Fundus photo — 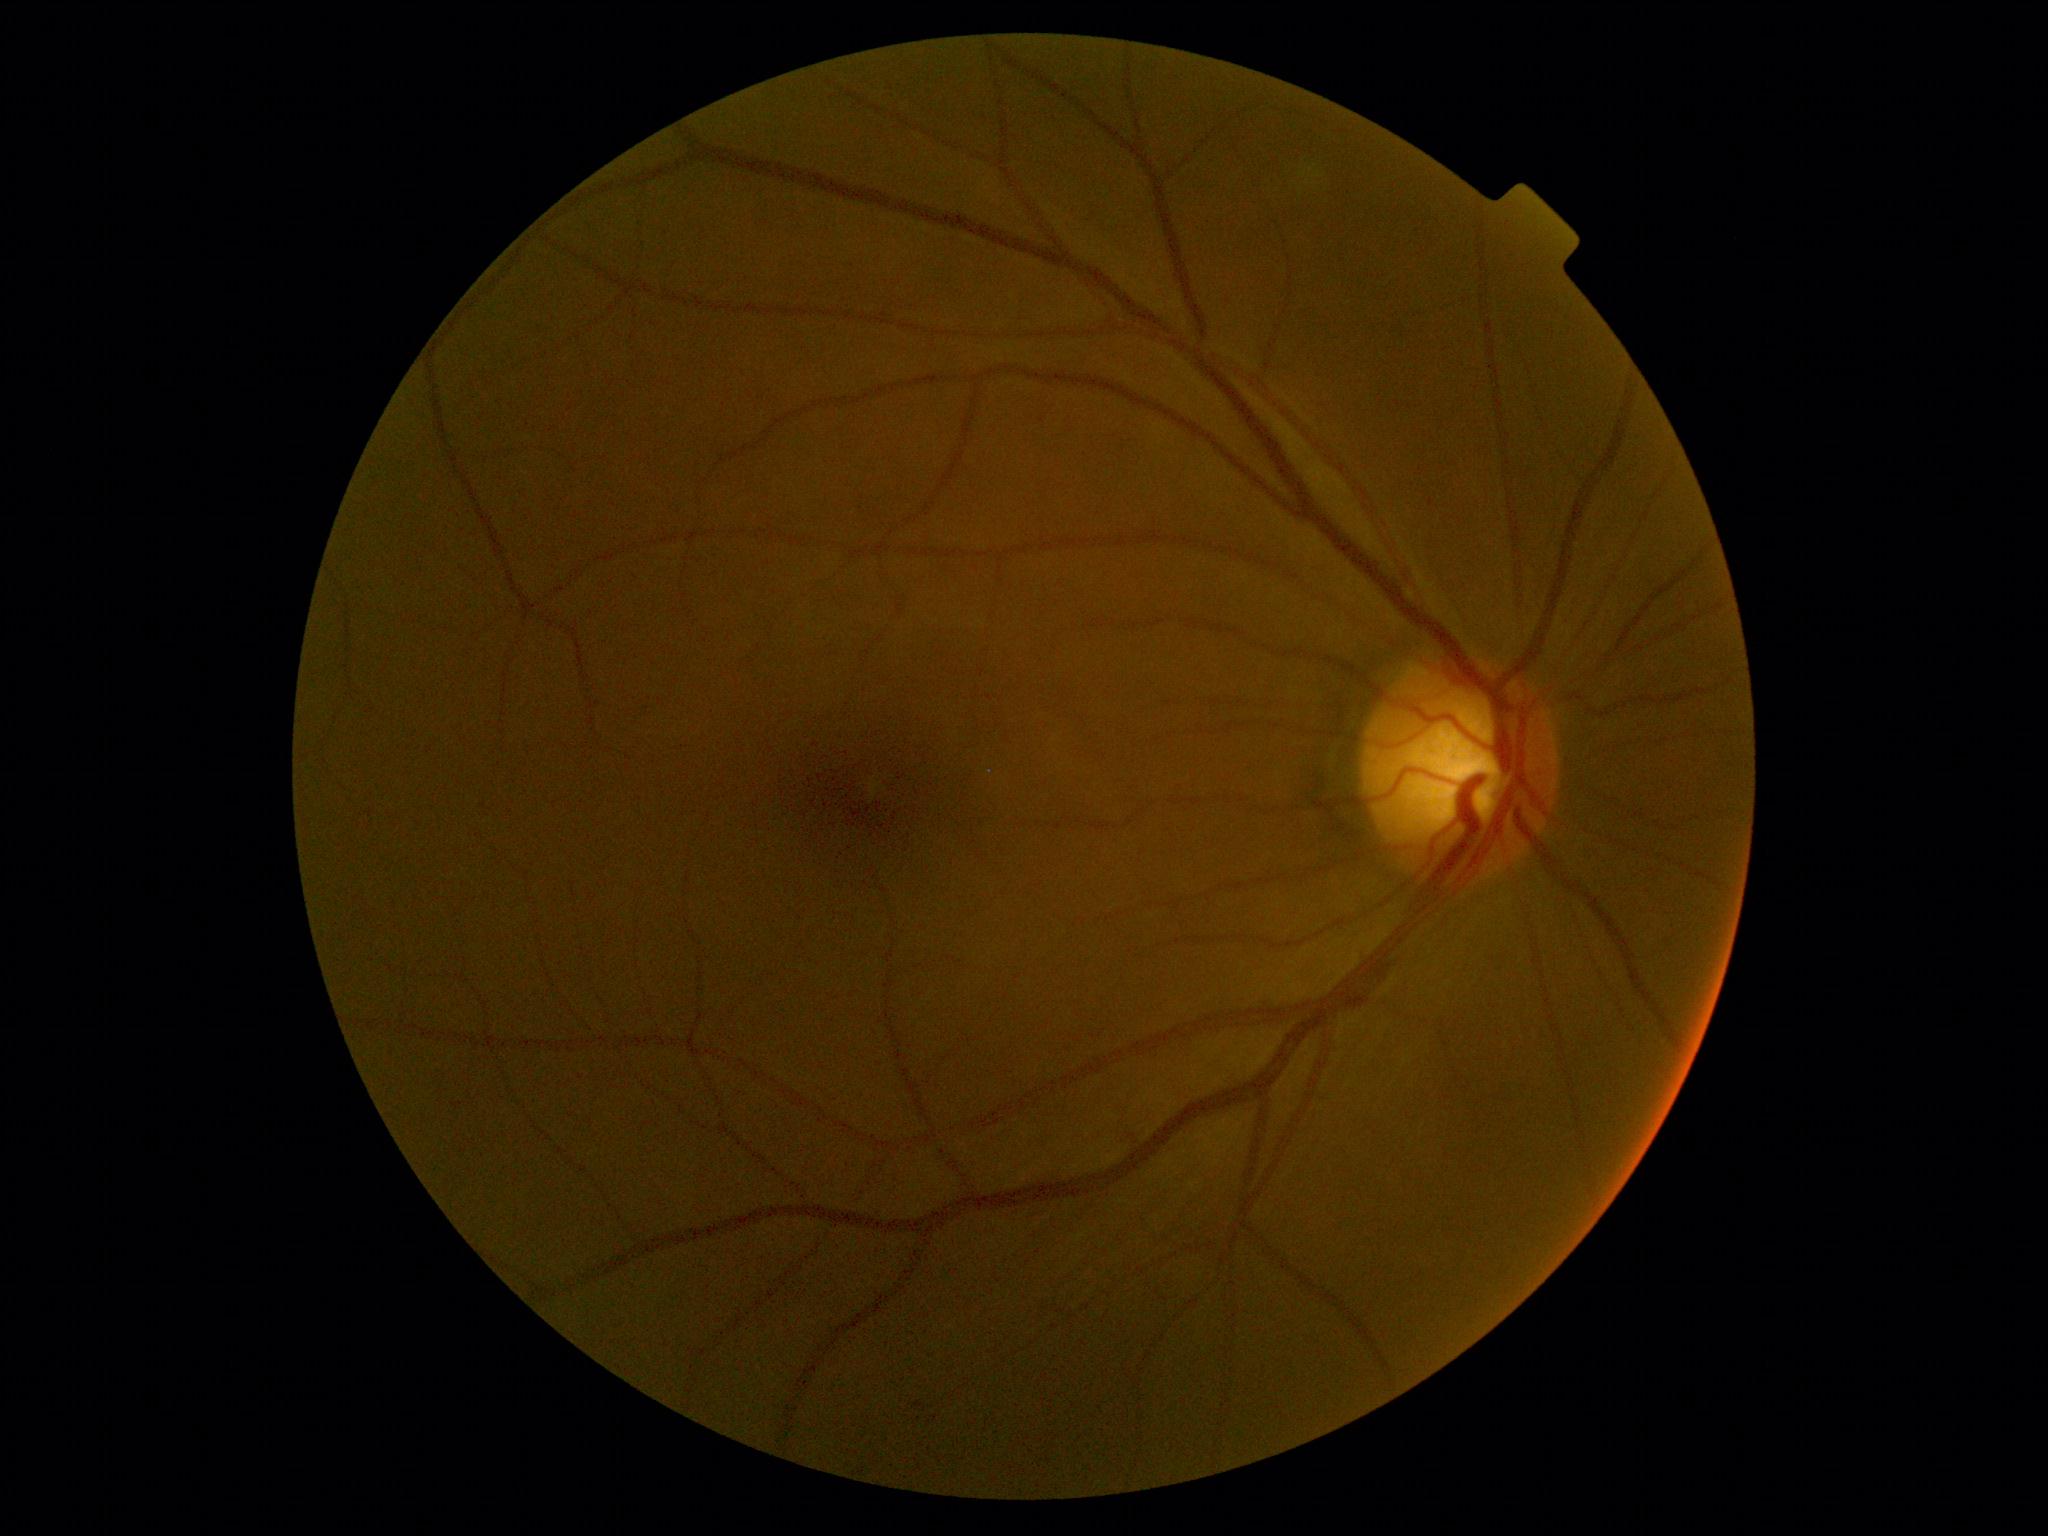
Annotations:
* DR impression — no apparent DR
* retinopathy grade — no apparent retinopathy (0)